848x848px; 45 degree fundus photograph — 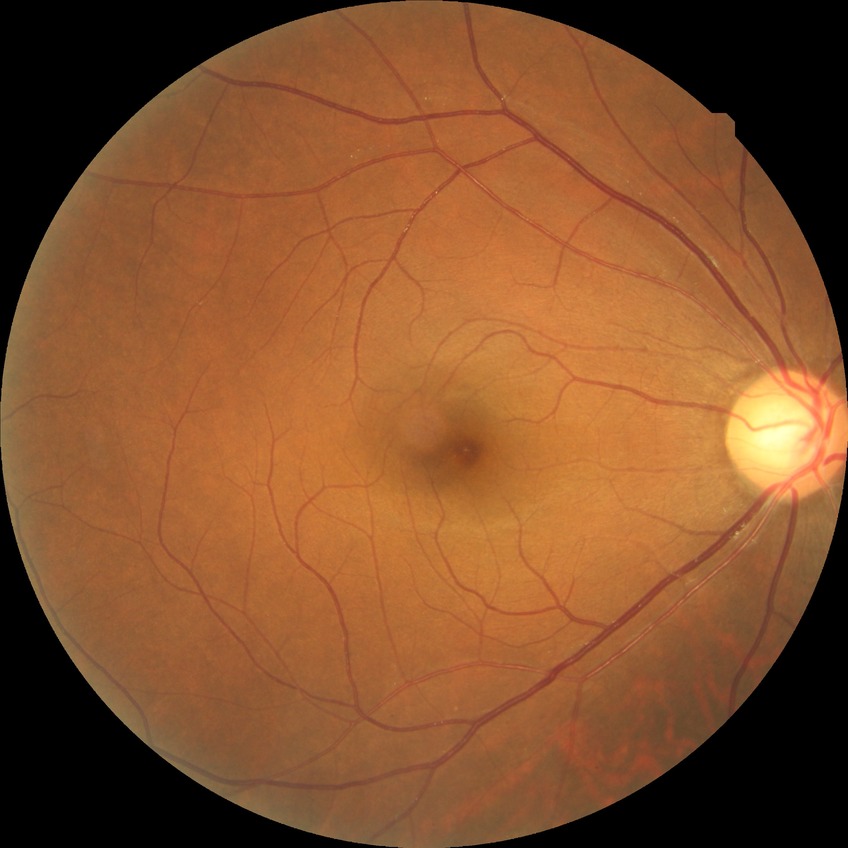

Diabetic retinopathy (DR): no diabetic retinopathy (NDR).